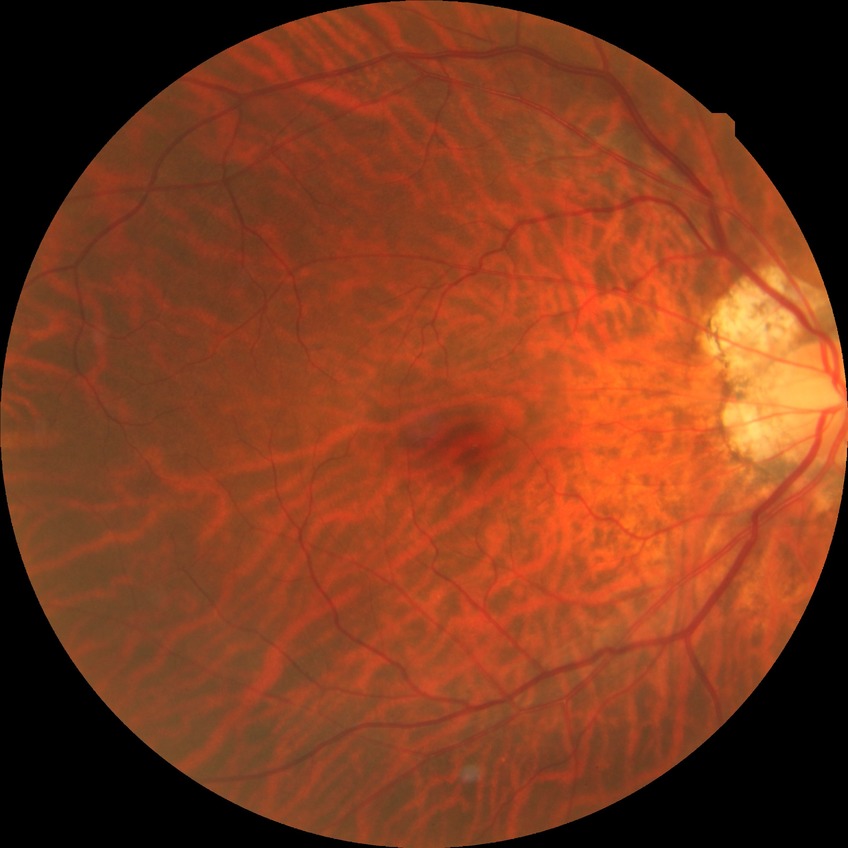 Annotations:
* Davis grading — no diabetic retinopathy